848 by 848 pixels · NIDEK AFC-230 · fundus photo: 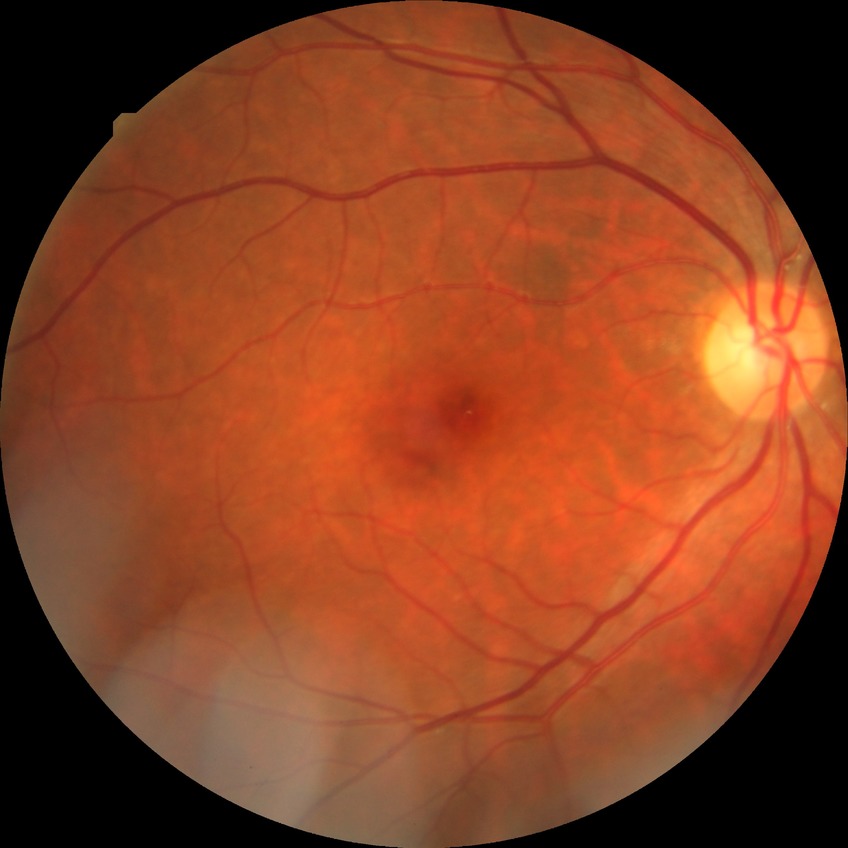 {"davis_grade": "no diabetic retinopathy"}